100° field of view (Phoenix ICON) · Phoenix ICON wide-field infant fundus image:
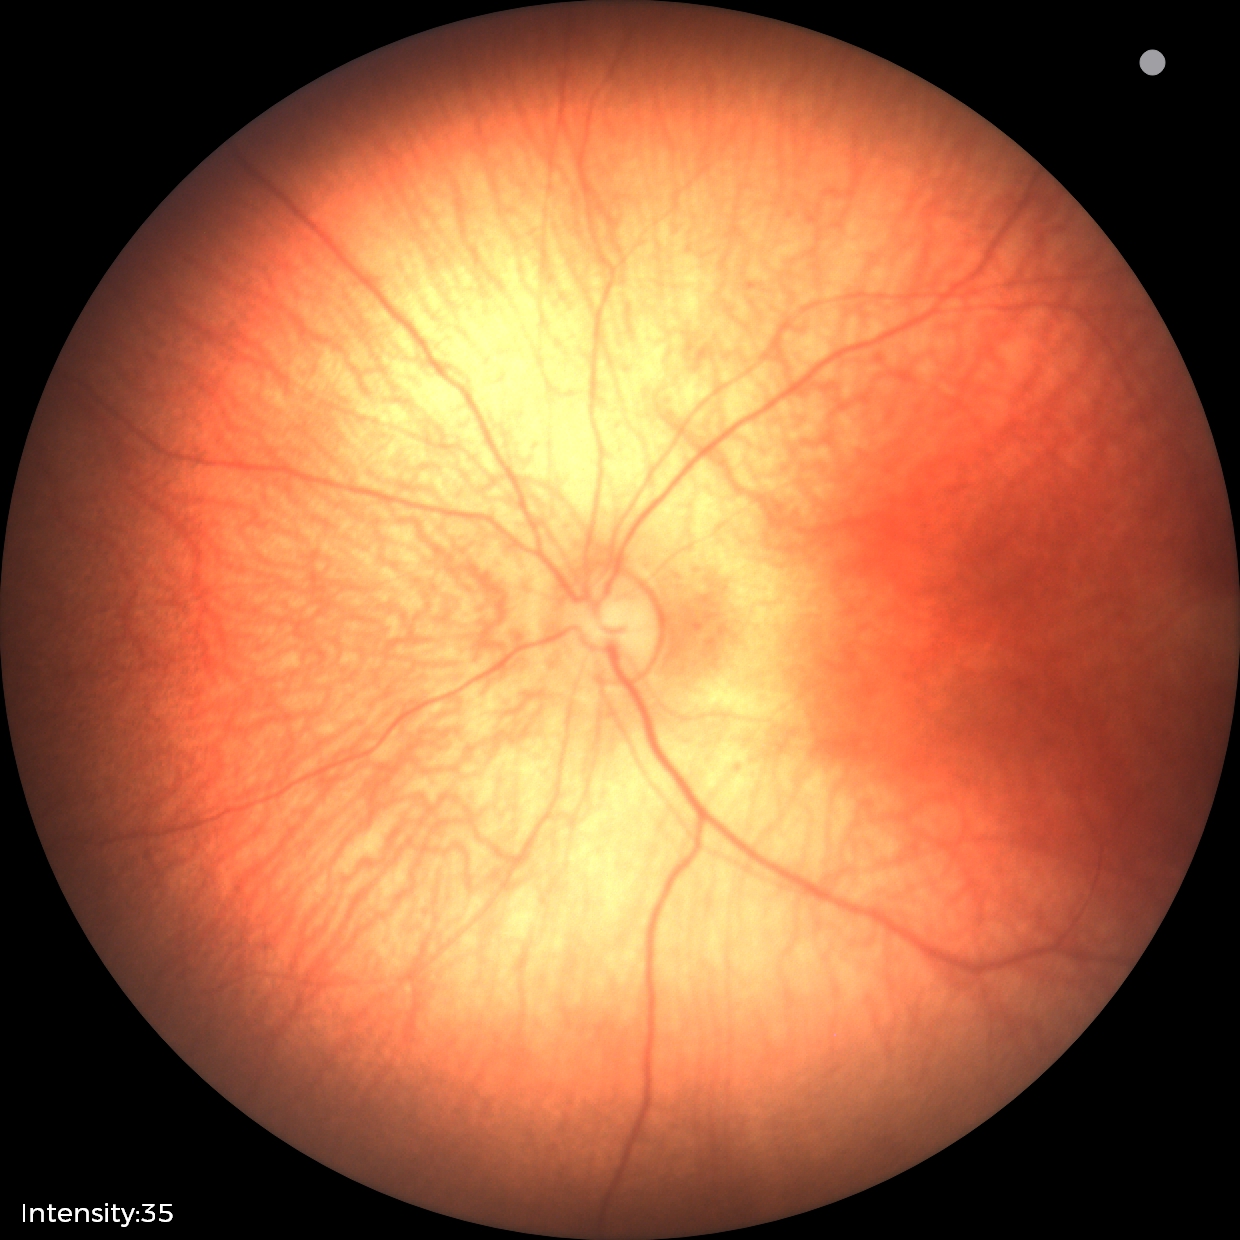 Screening examination with no abnormal retinal findings.